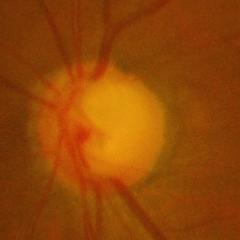 Glaucoma is present. Glaucoma stage = advanced glaucoma.